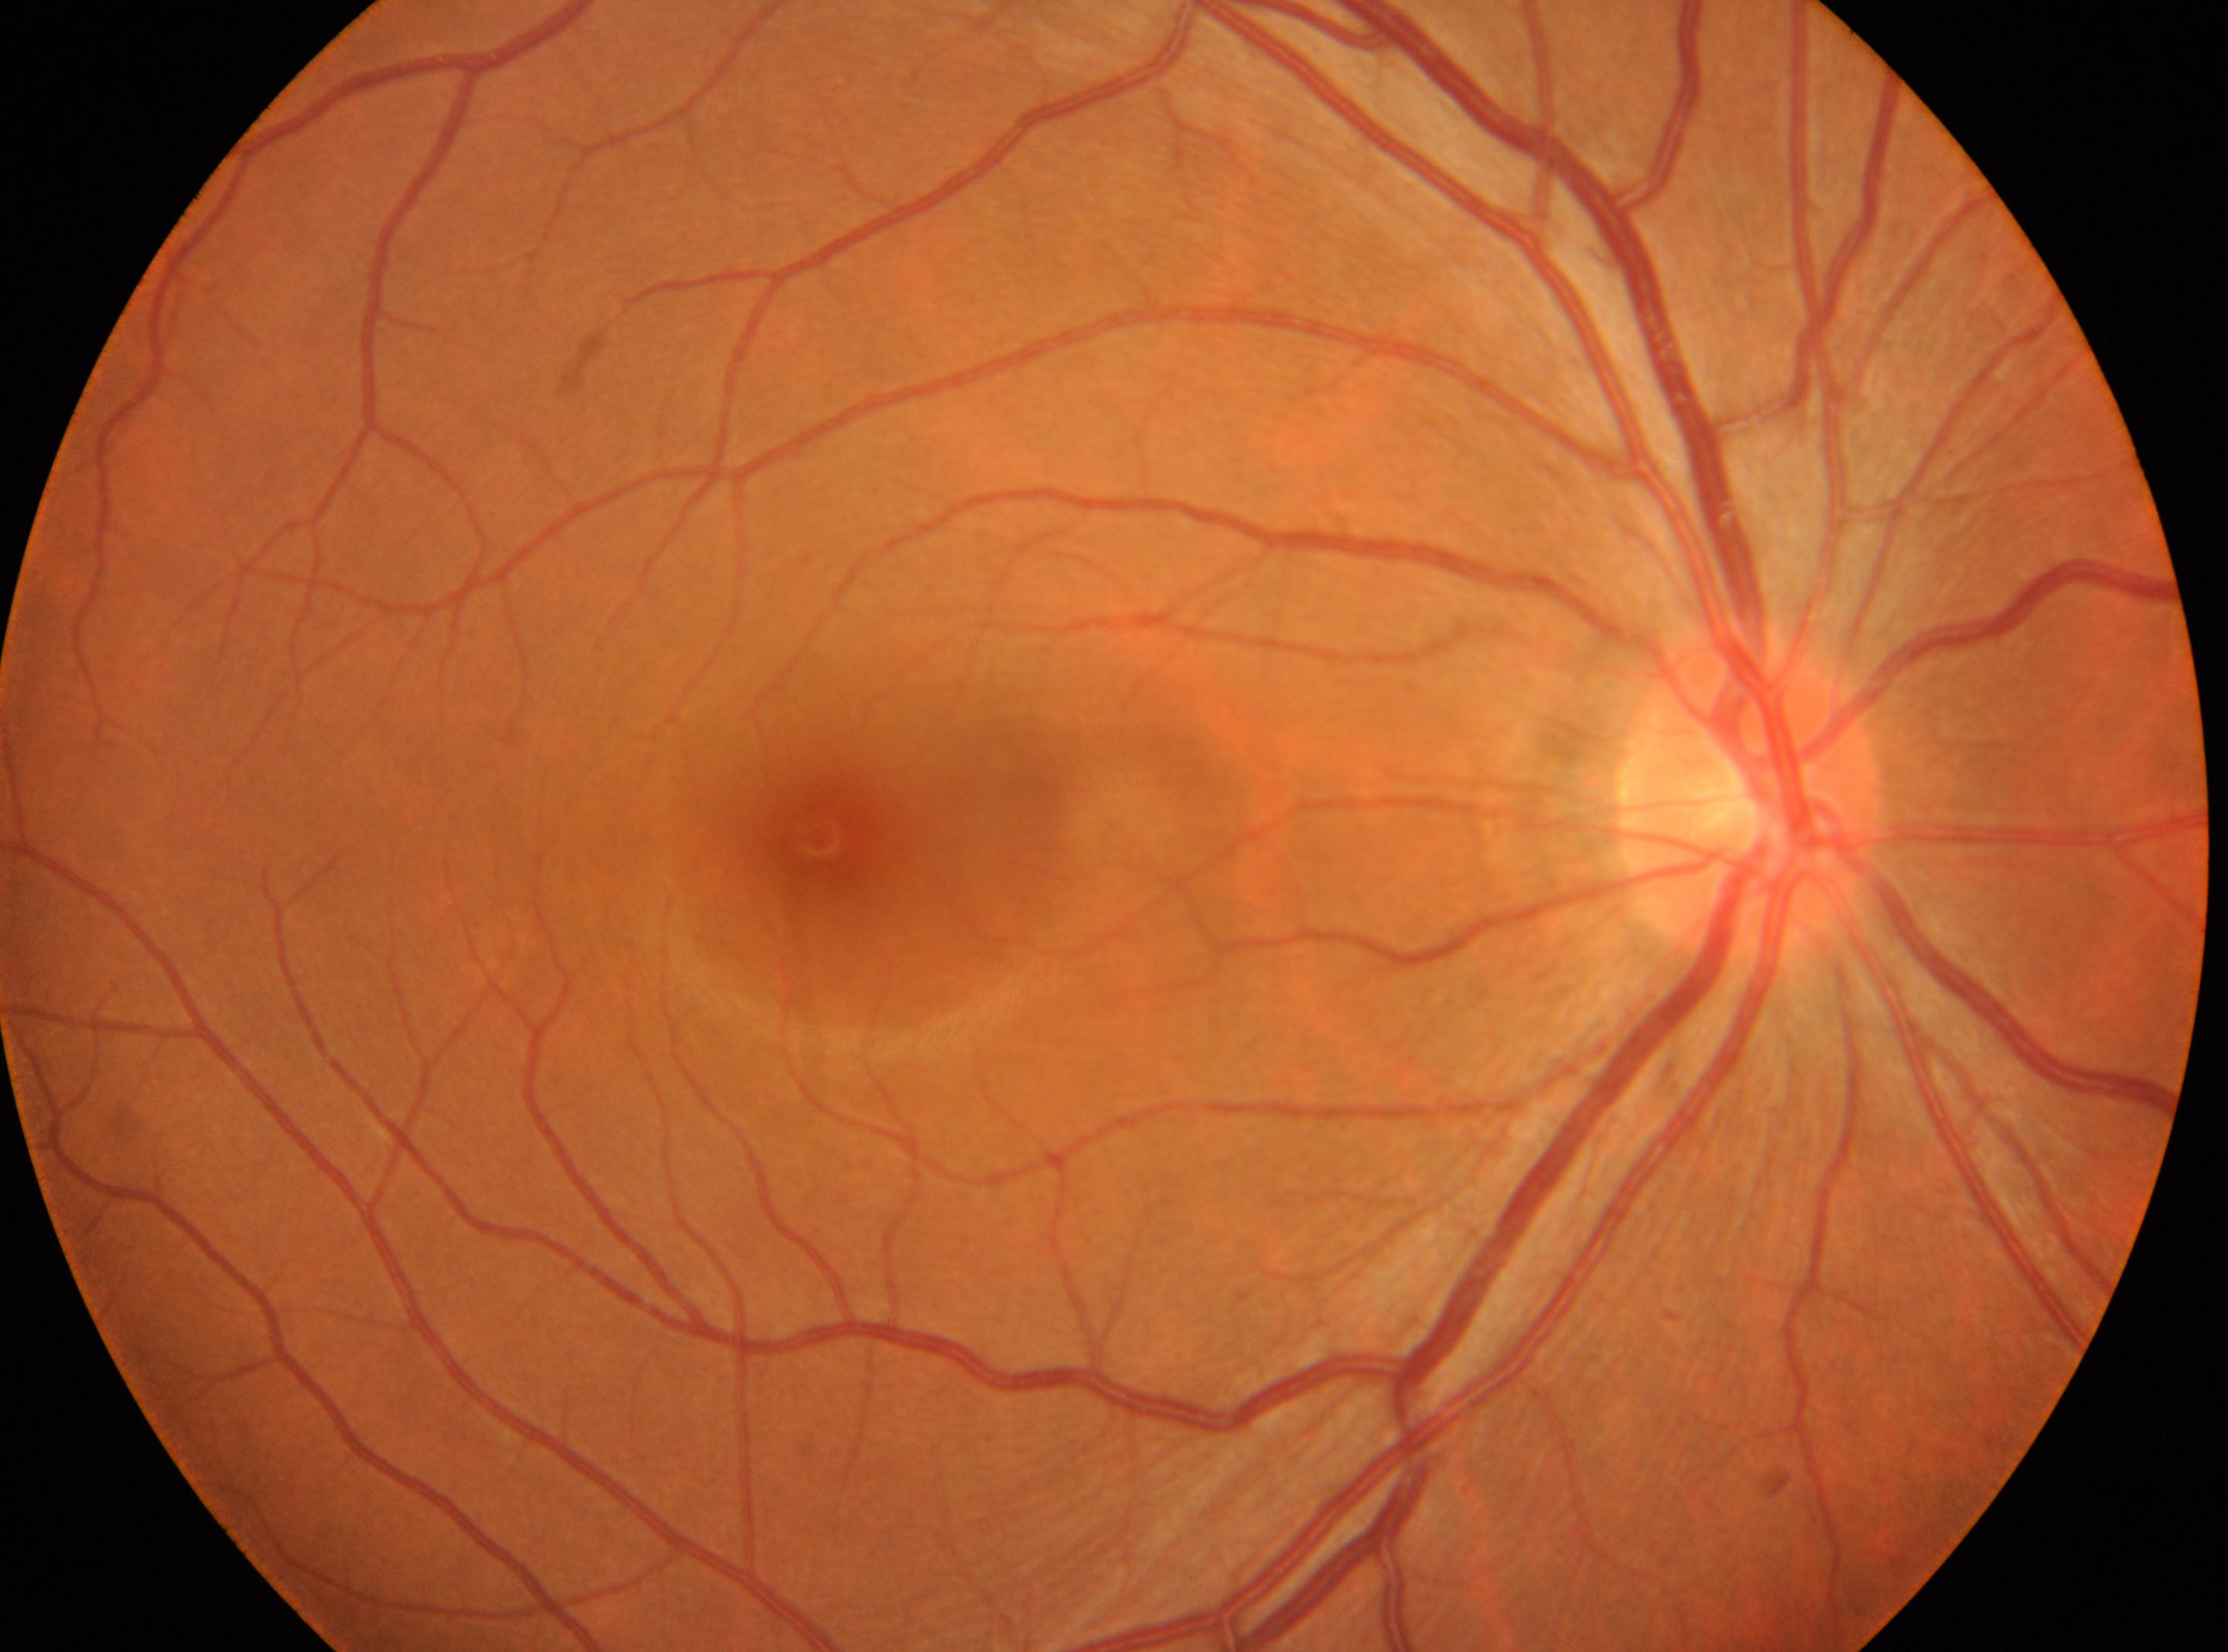 optic disc: x=1750, y=798 | diabetic retinopathy grade: 0 | foveal center: x=820, y=838 | eye: OD.